Modified Davis grading, no pharmacologic dilation, 45° FOV, NIDEK AFC-230 fundus camera, color fundus photograph:
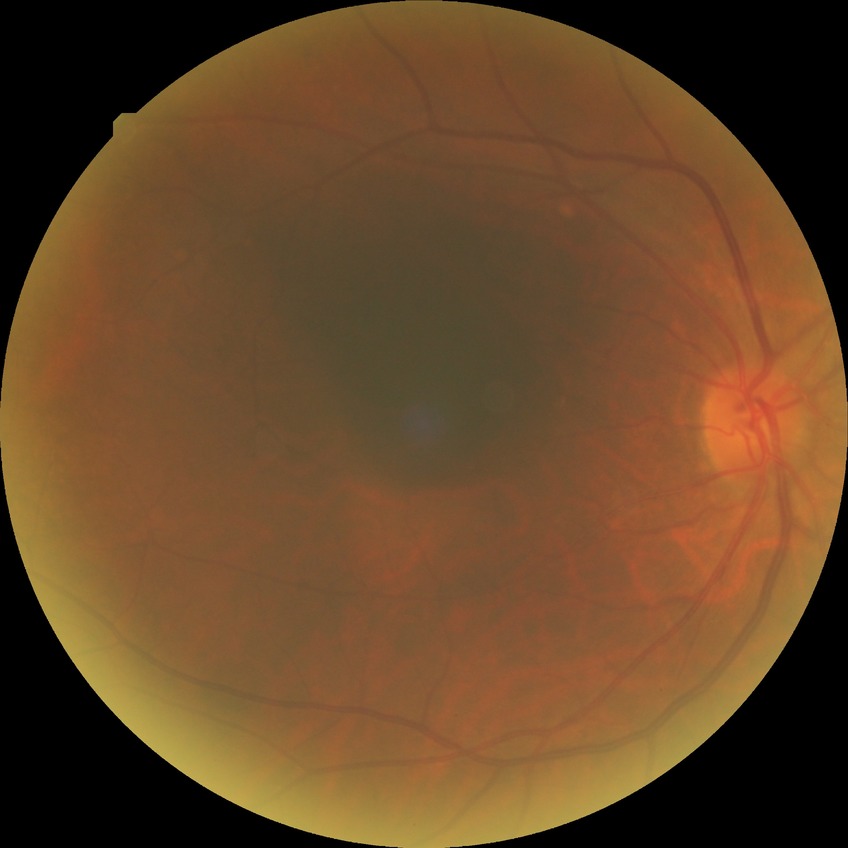 The retinopathy is classified as non-proliferative diabetic retinopathy.
Davis grade: SDR.